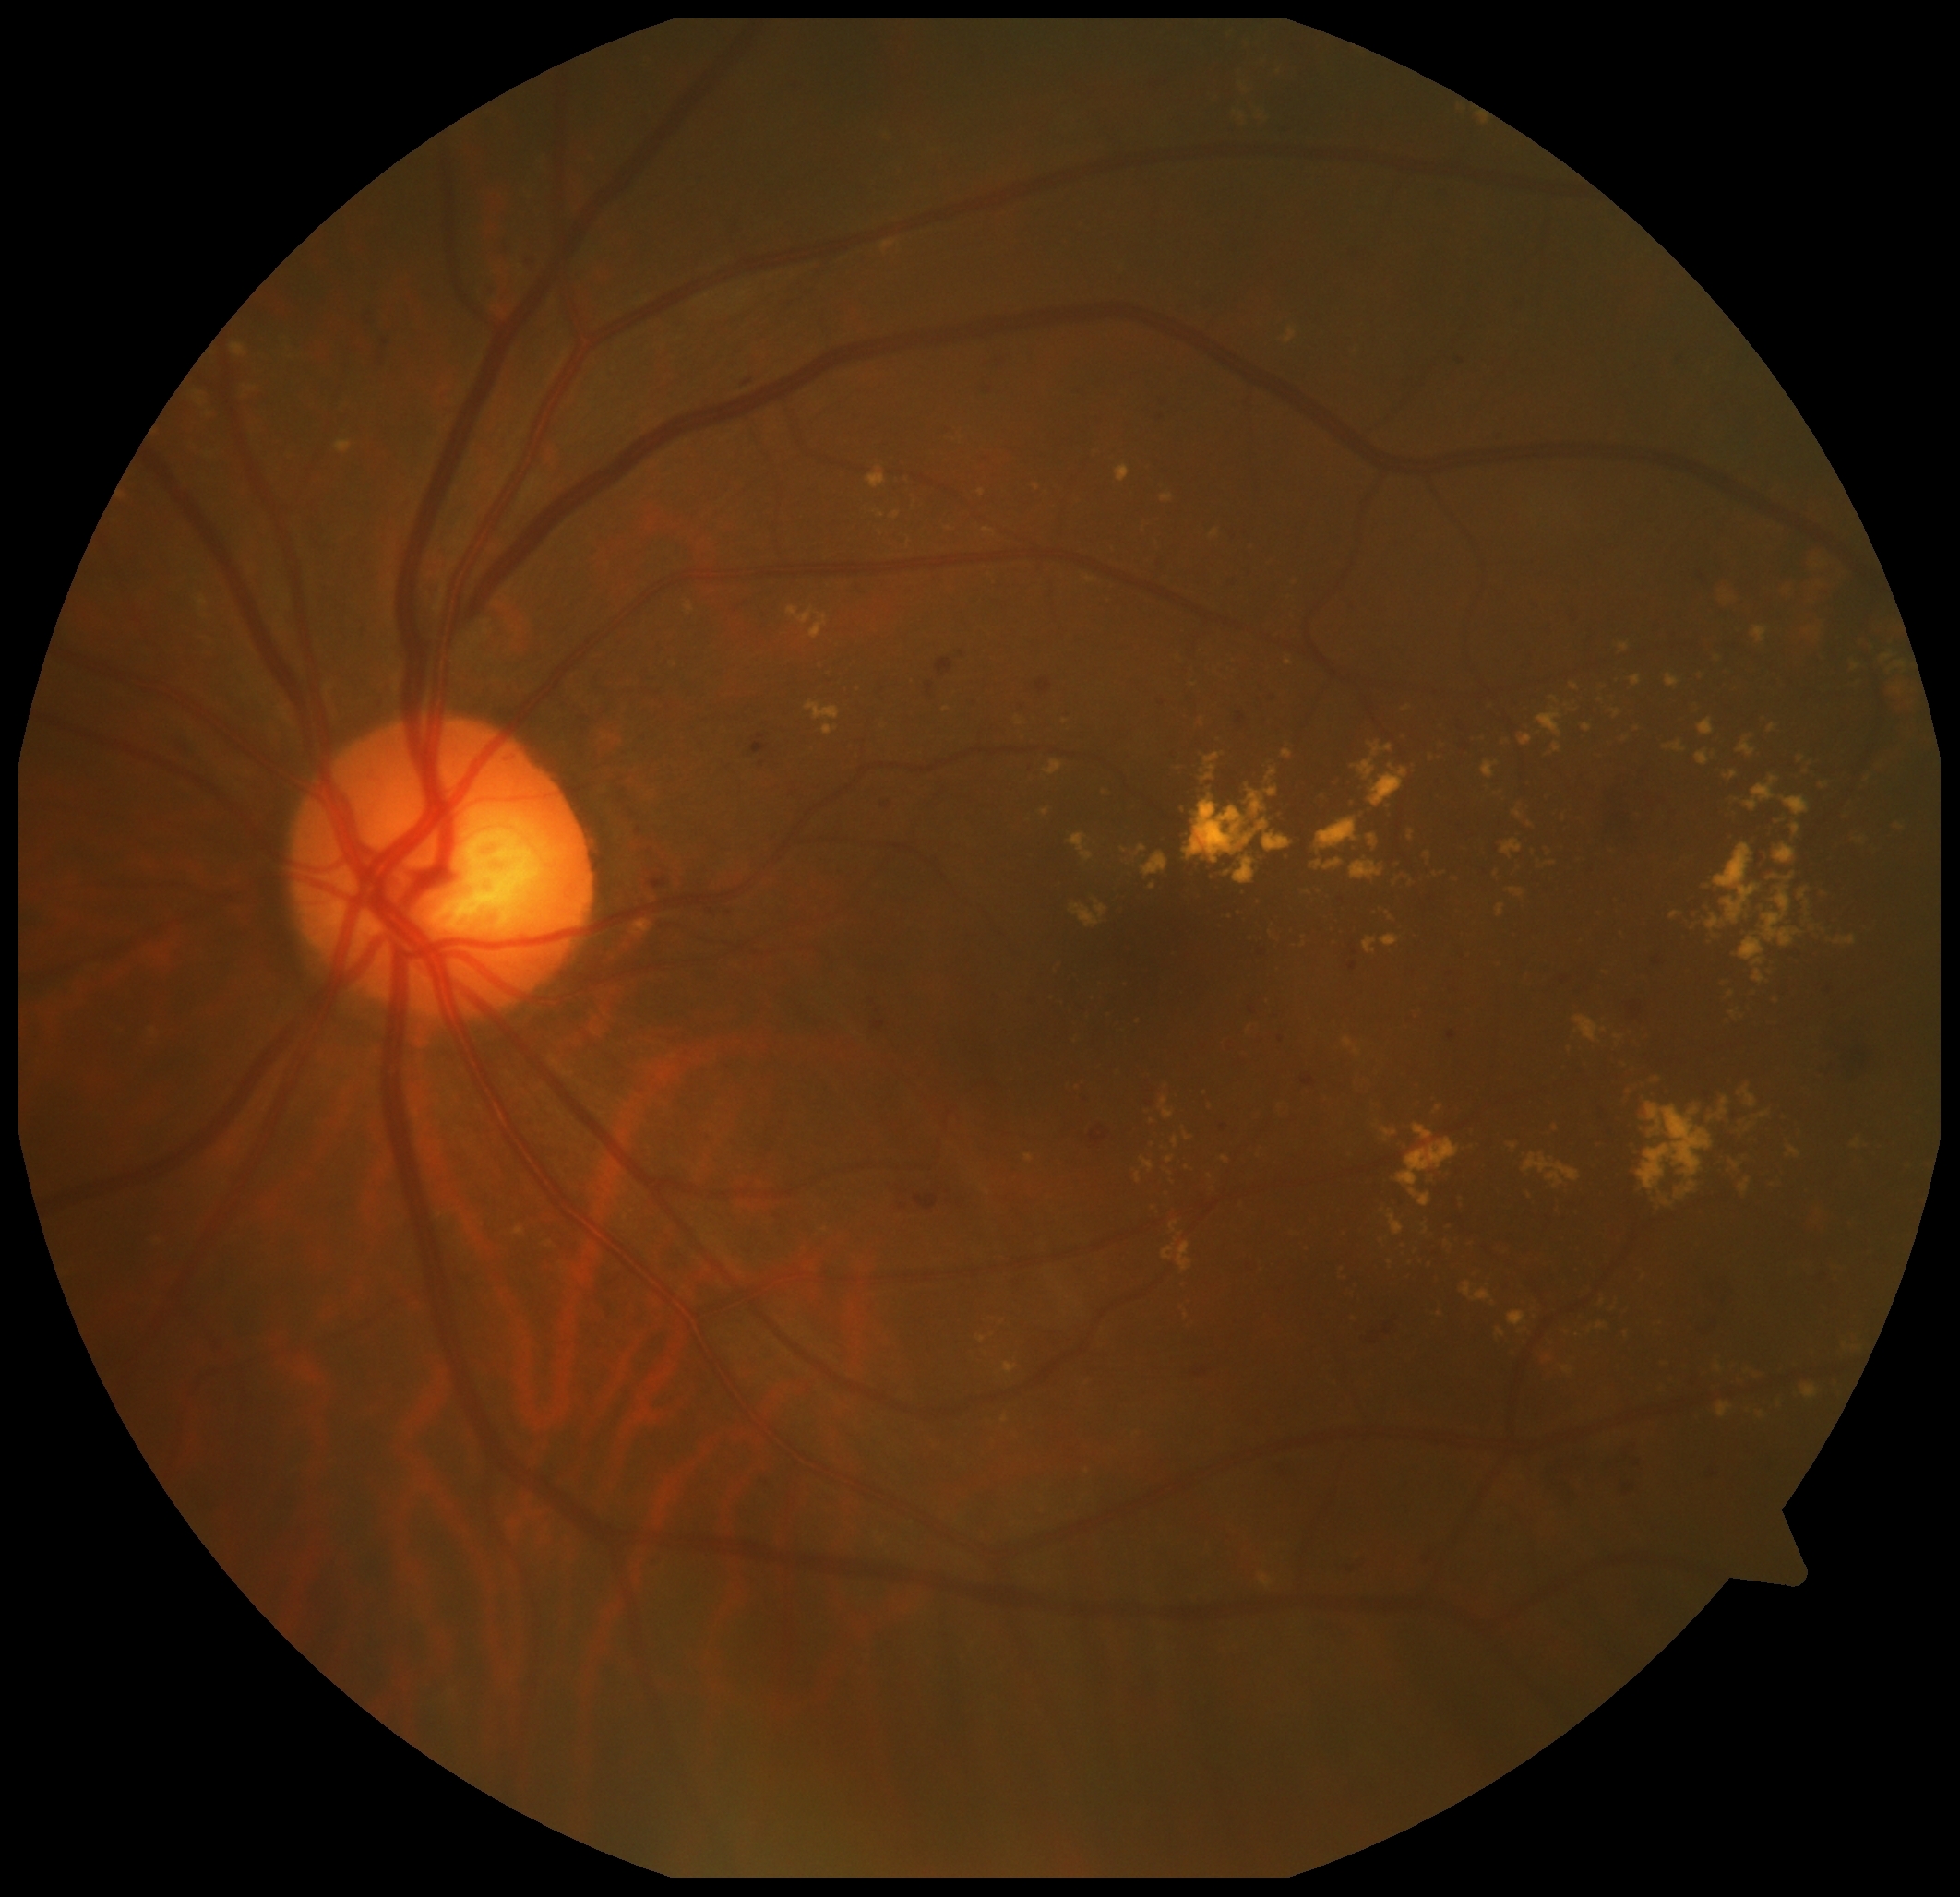
The retinopathy is classified as non-proliferative diabetic retinopathy. Diabetic retinopathy (DR): 2.